Image size 2228x1652; fundus photo
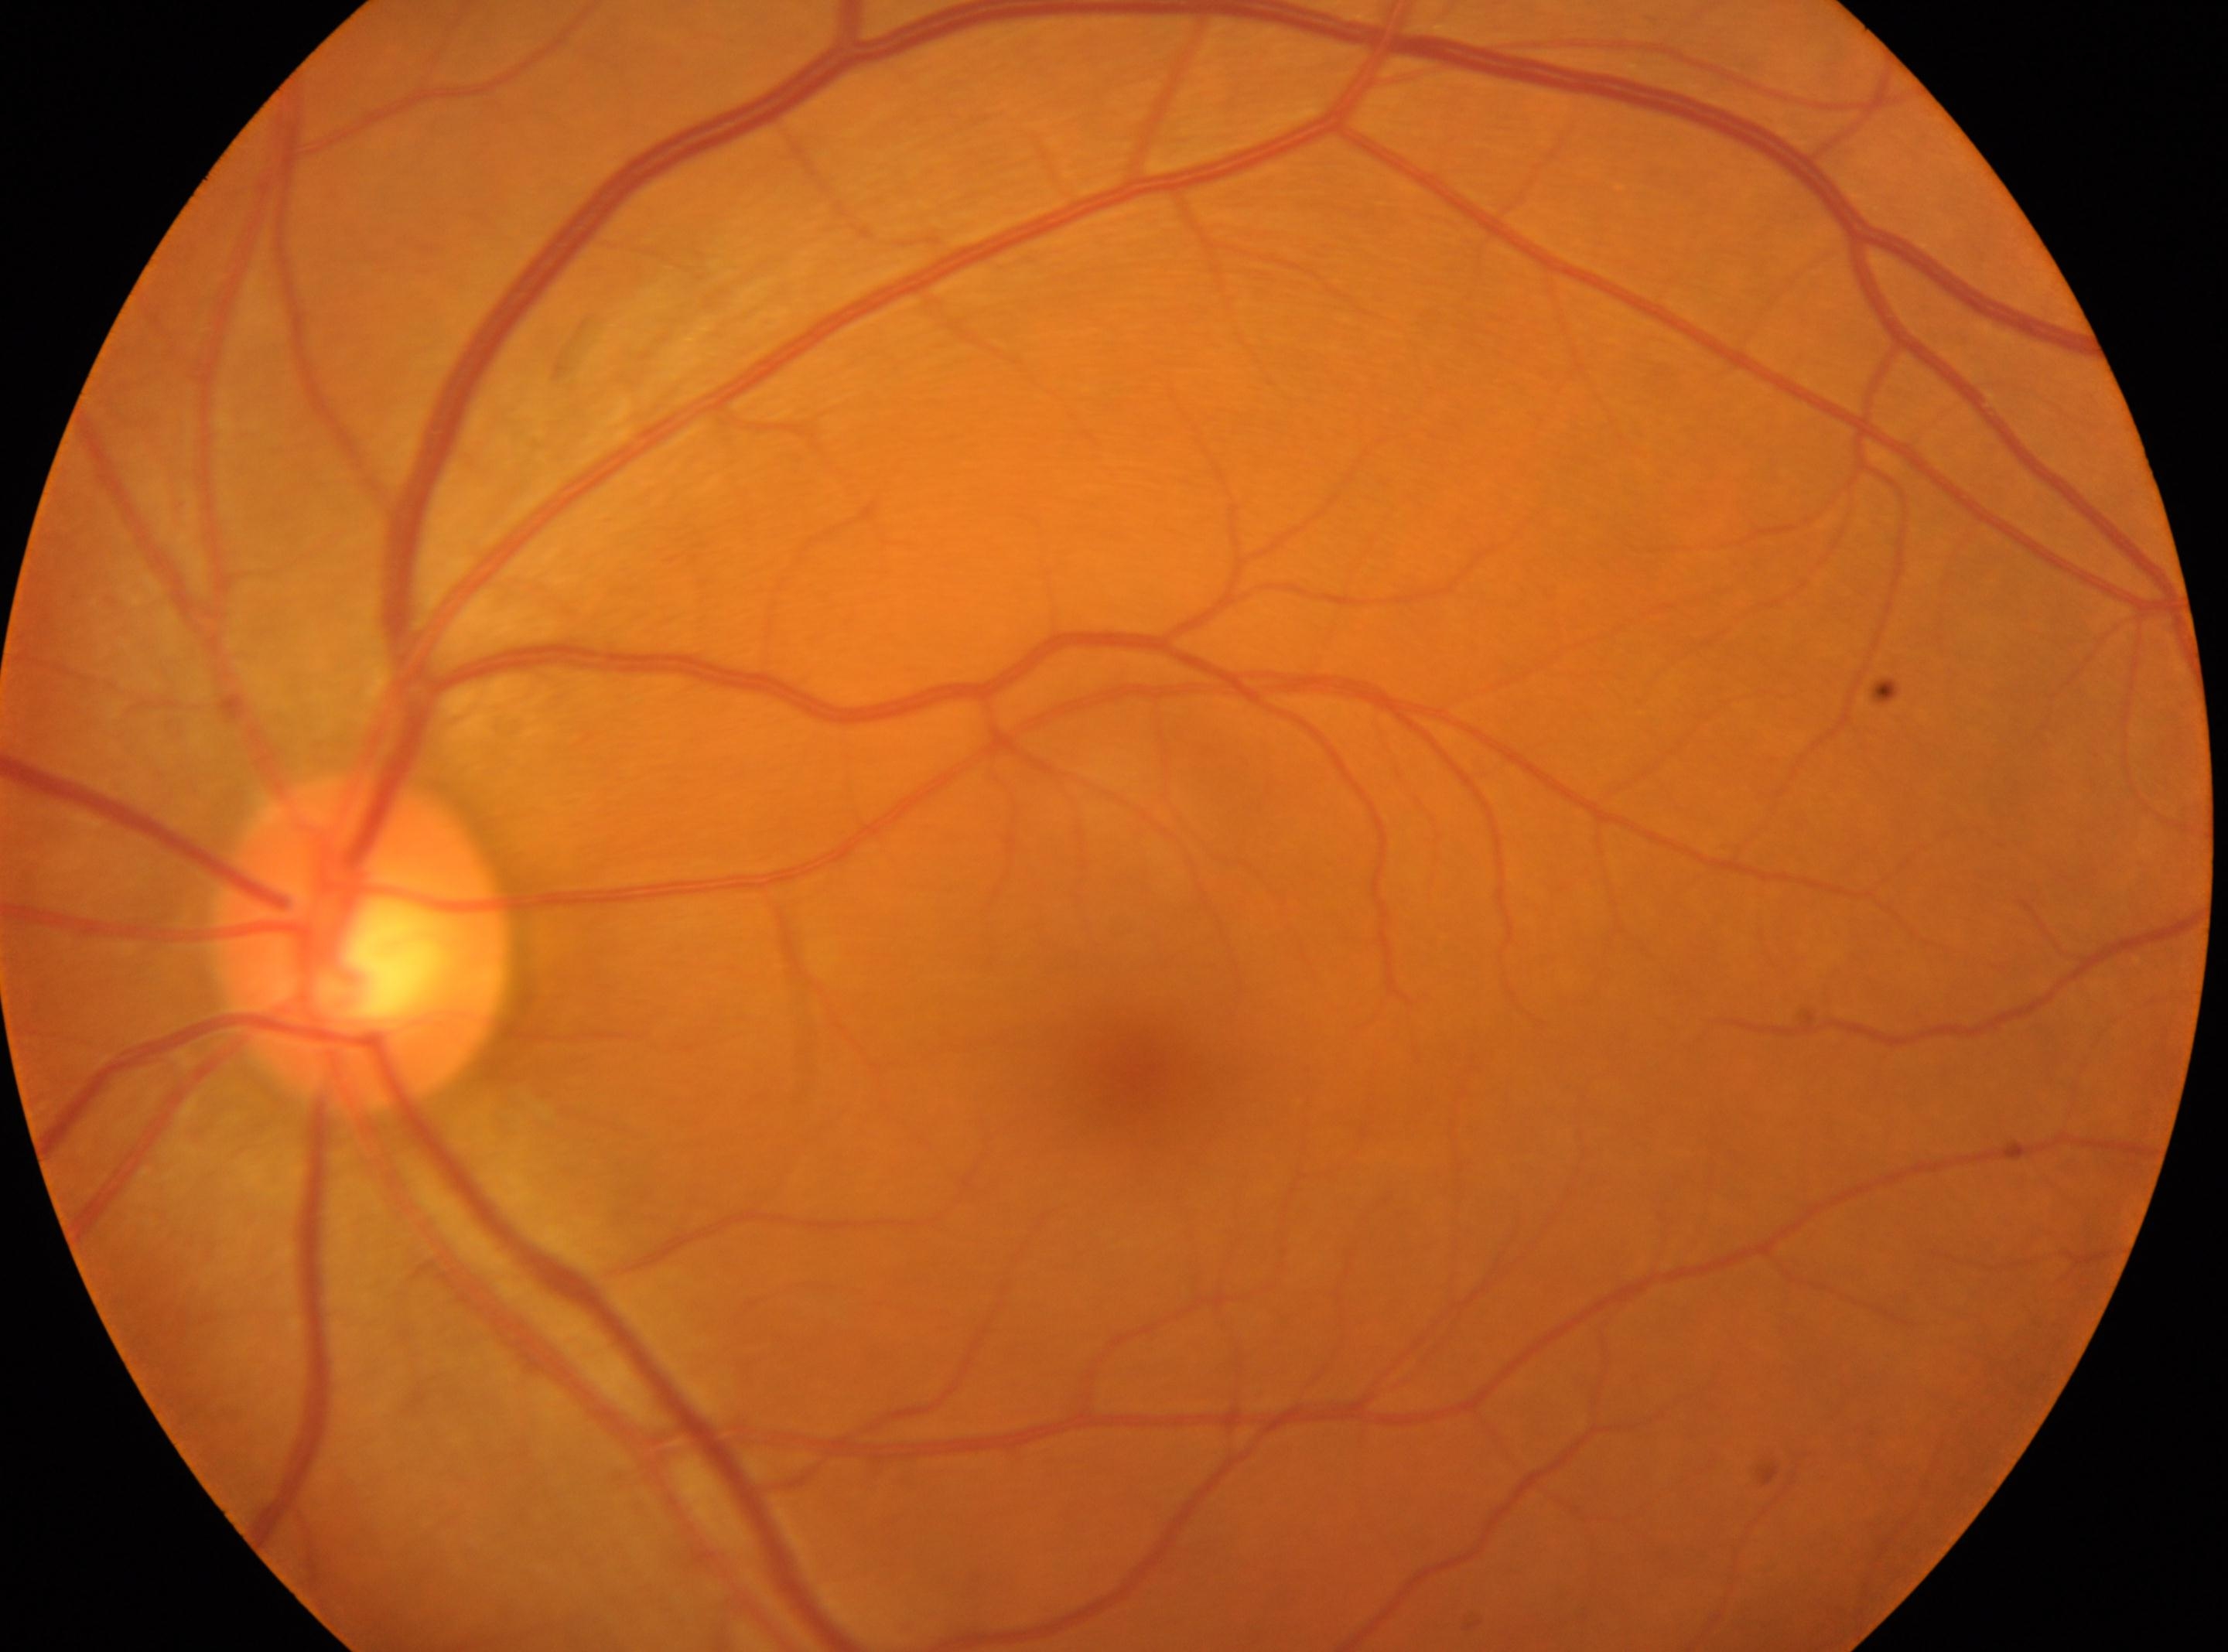

foveal center: [1128, 1081]
retinopathy grade: 0/4
OS
optic nerve head: [362, 942]